Handheld portable fundus camera image: 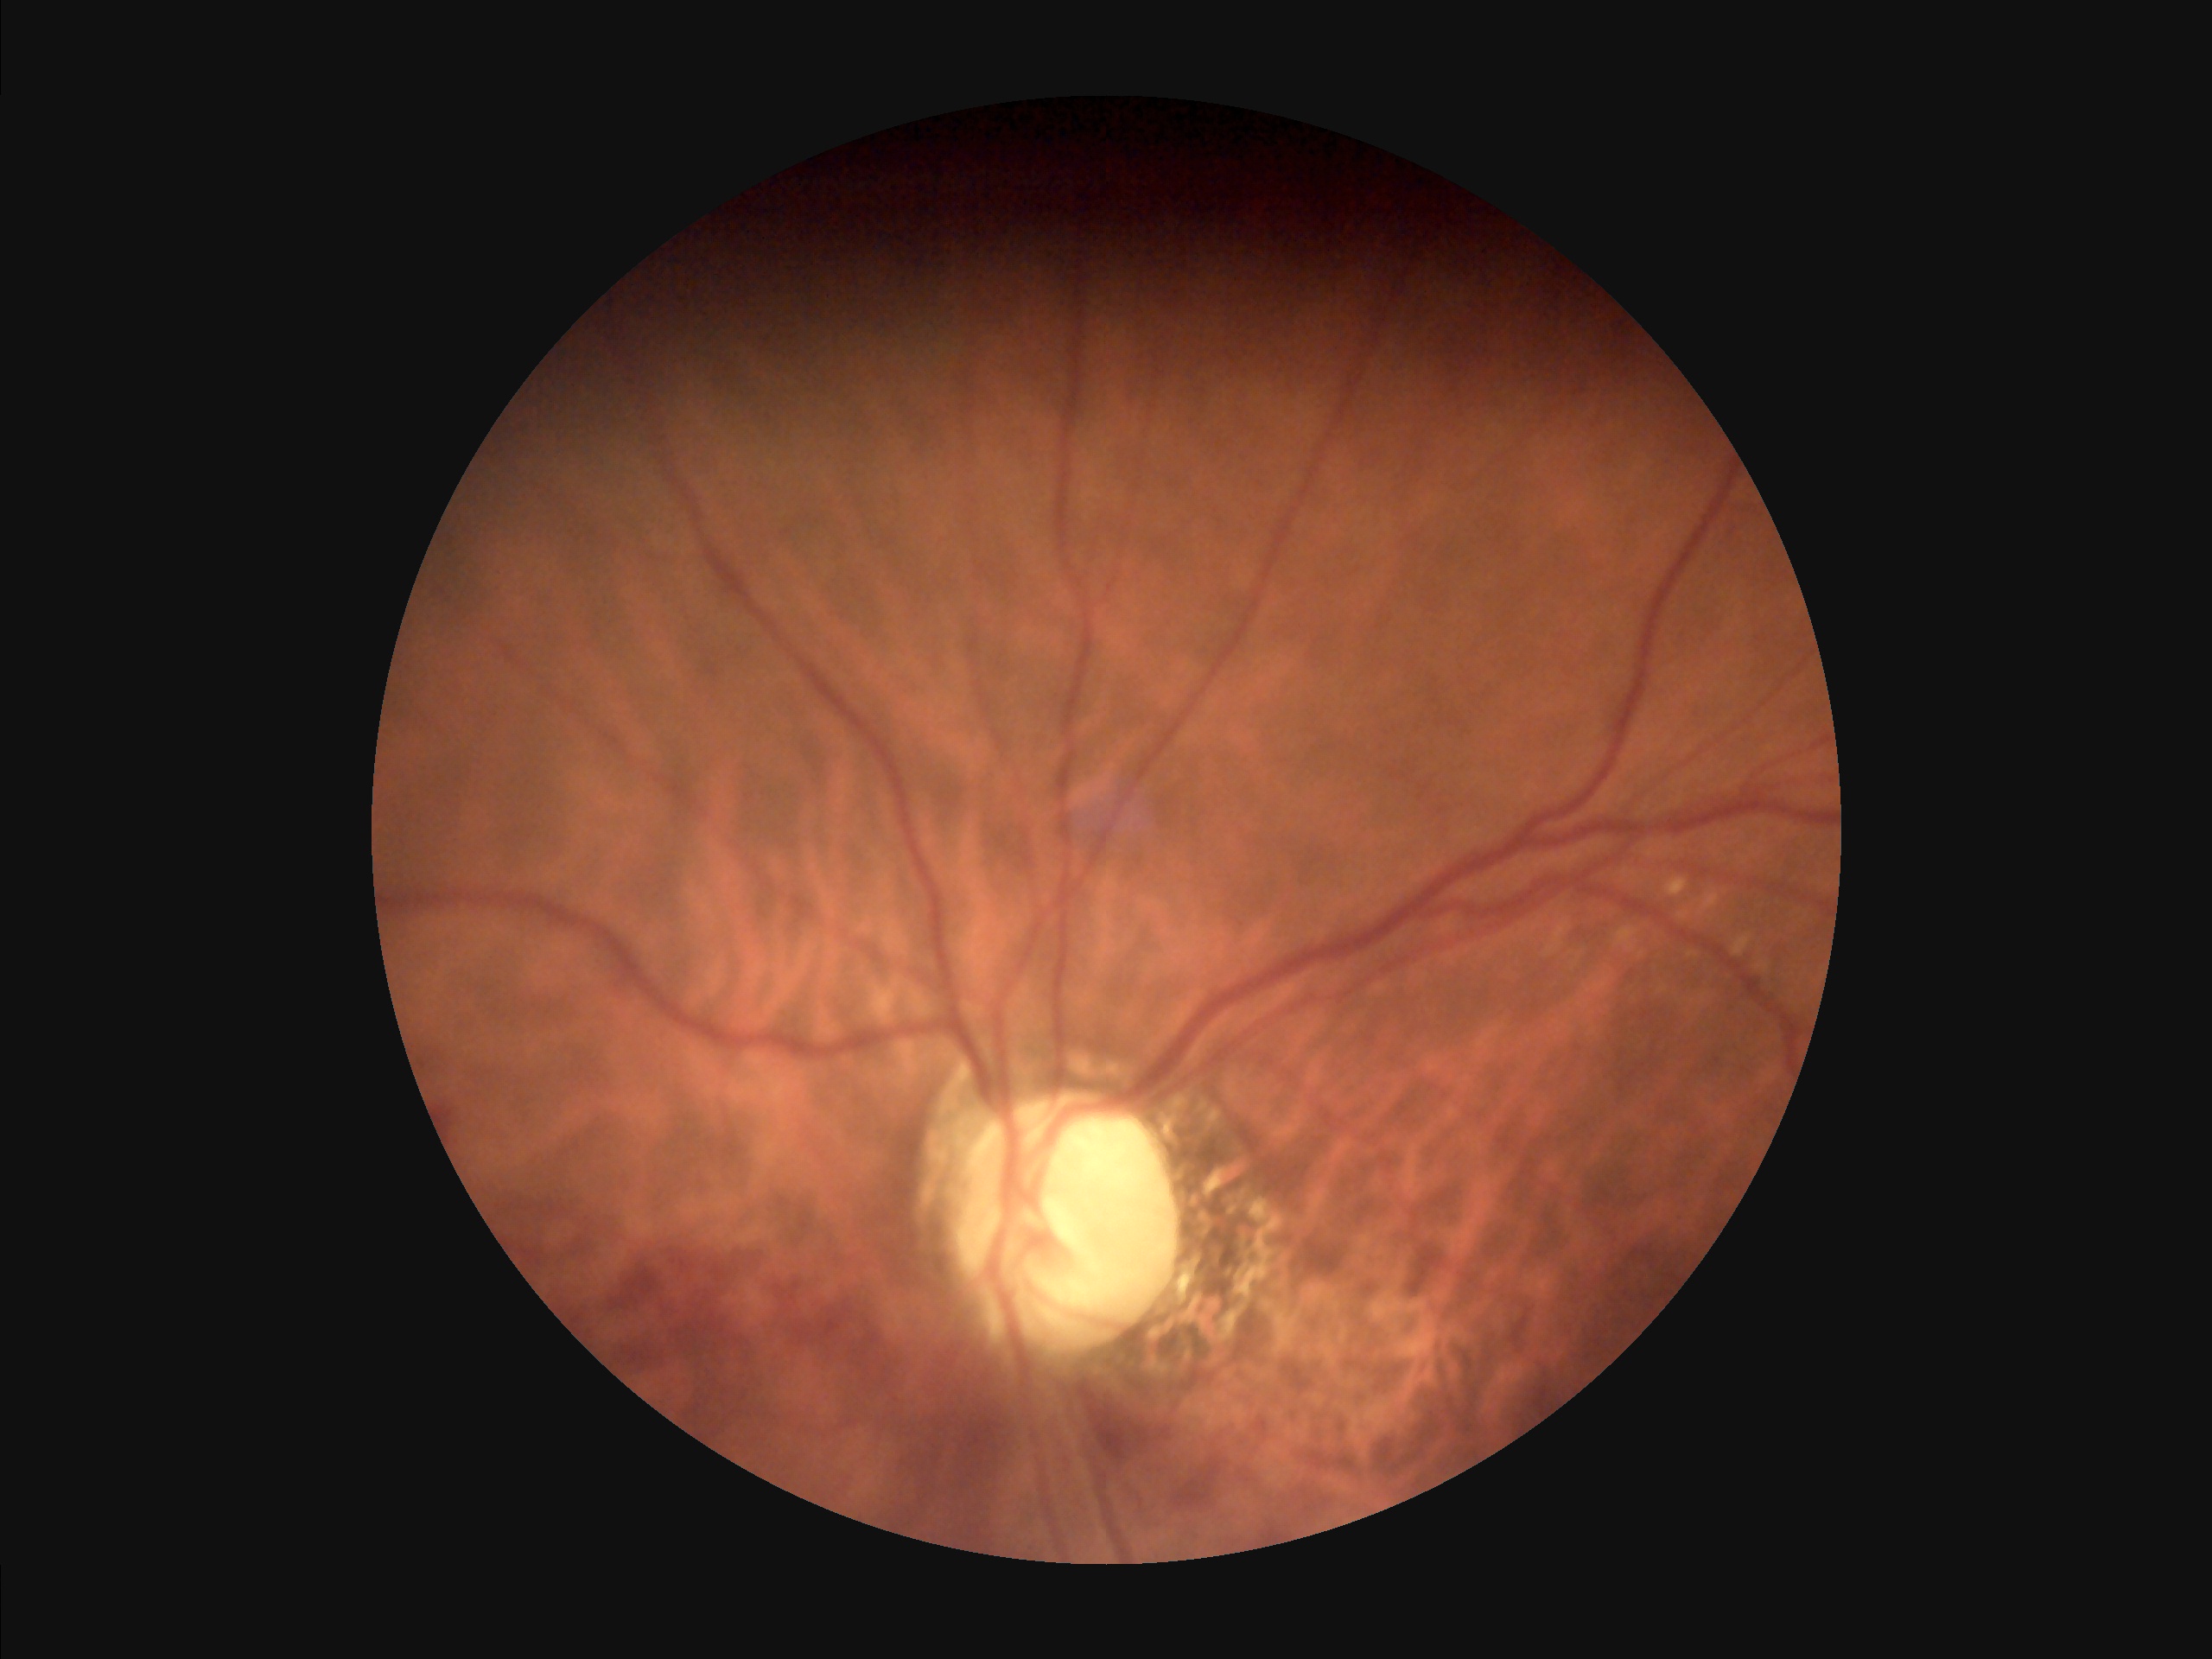

Even illumination with no color cast.
Optic disc, vessels, and background are in focus.
Good dynamic range.